45° field of view:
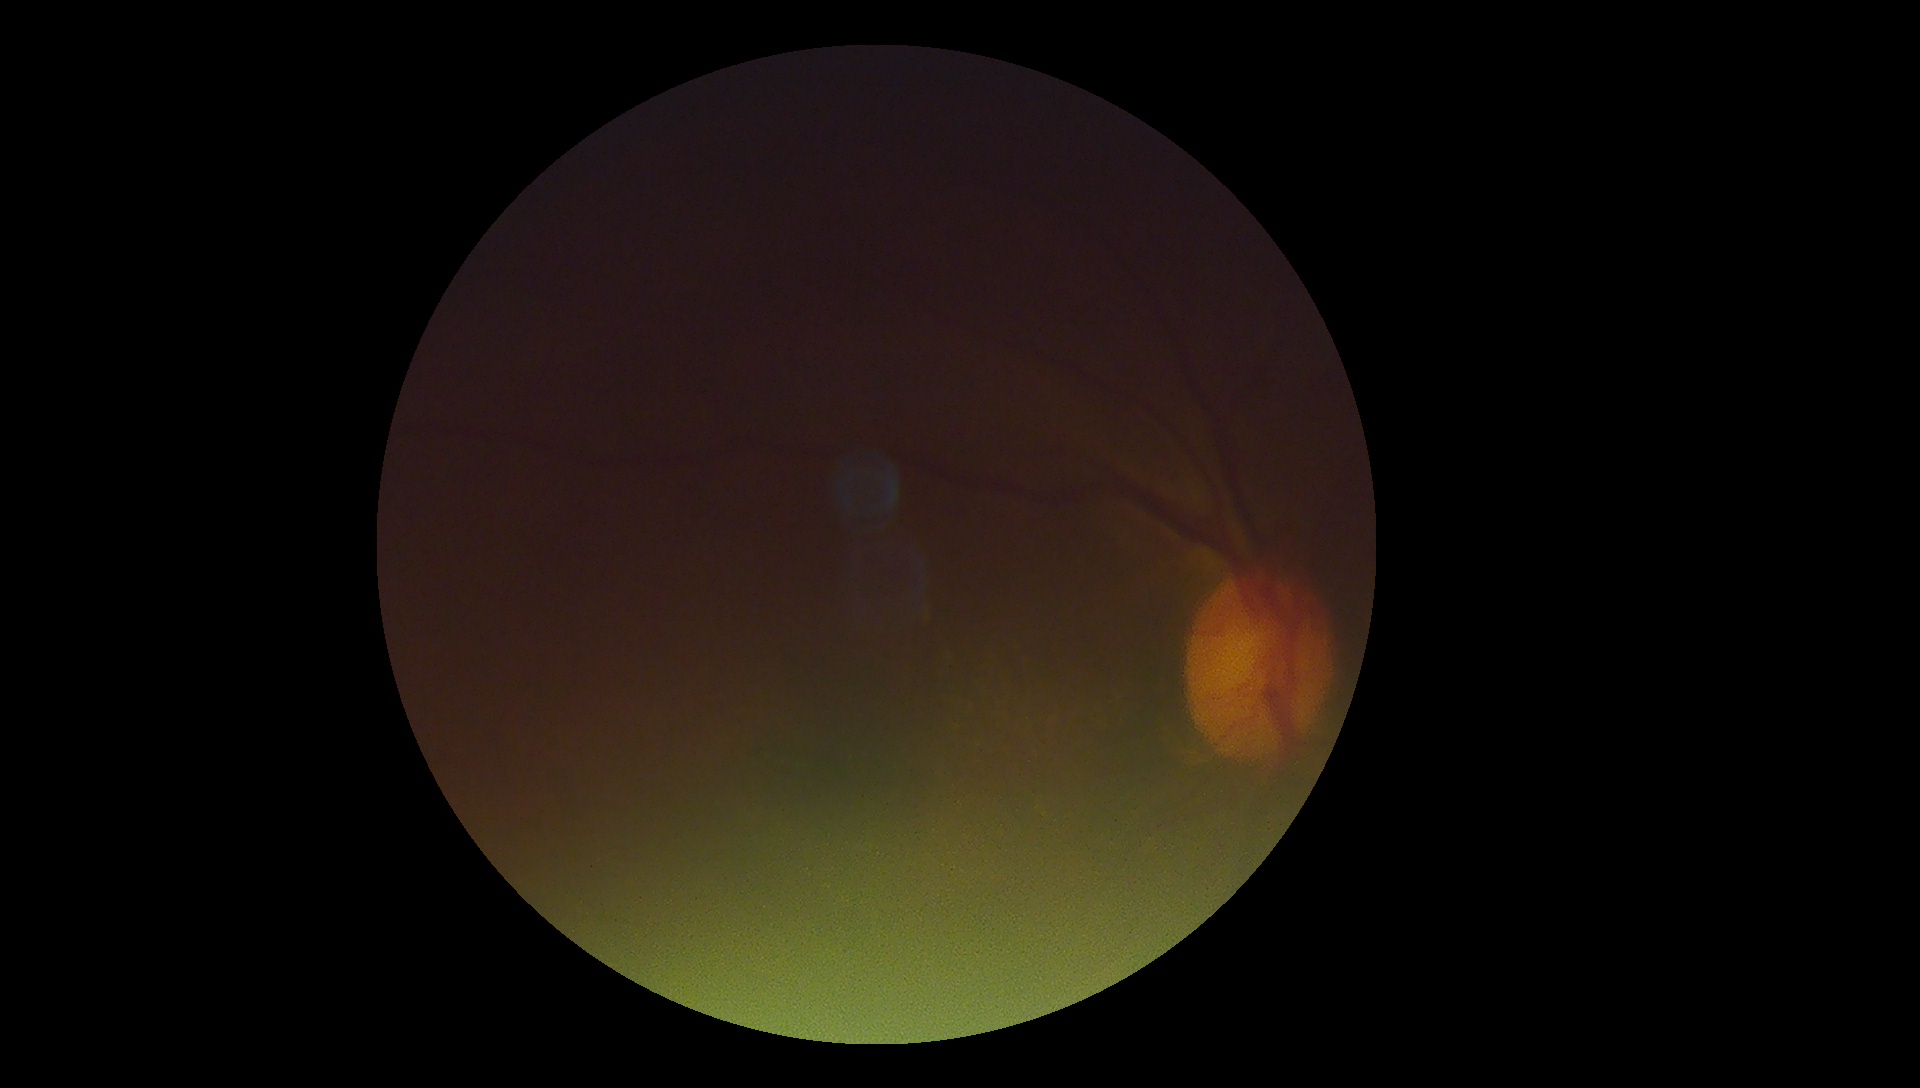 Retinopathy grade is ungradable due to poor image quality.
Quality too poor to assess for DR.